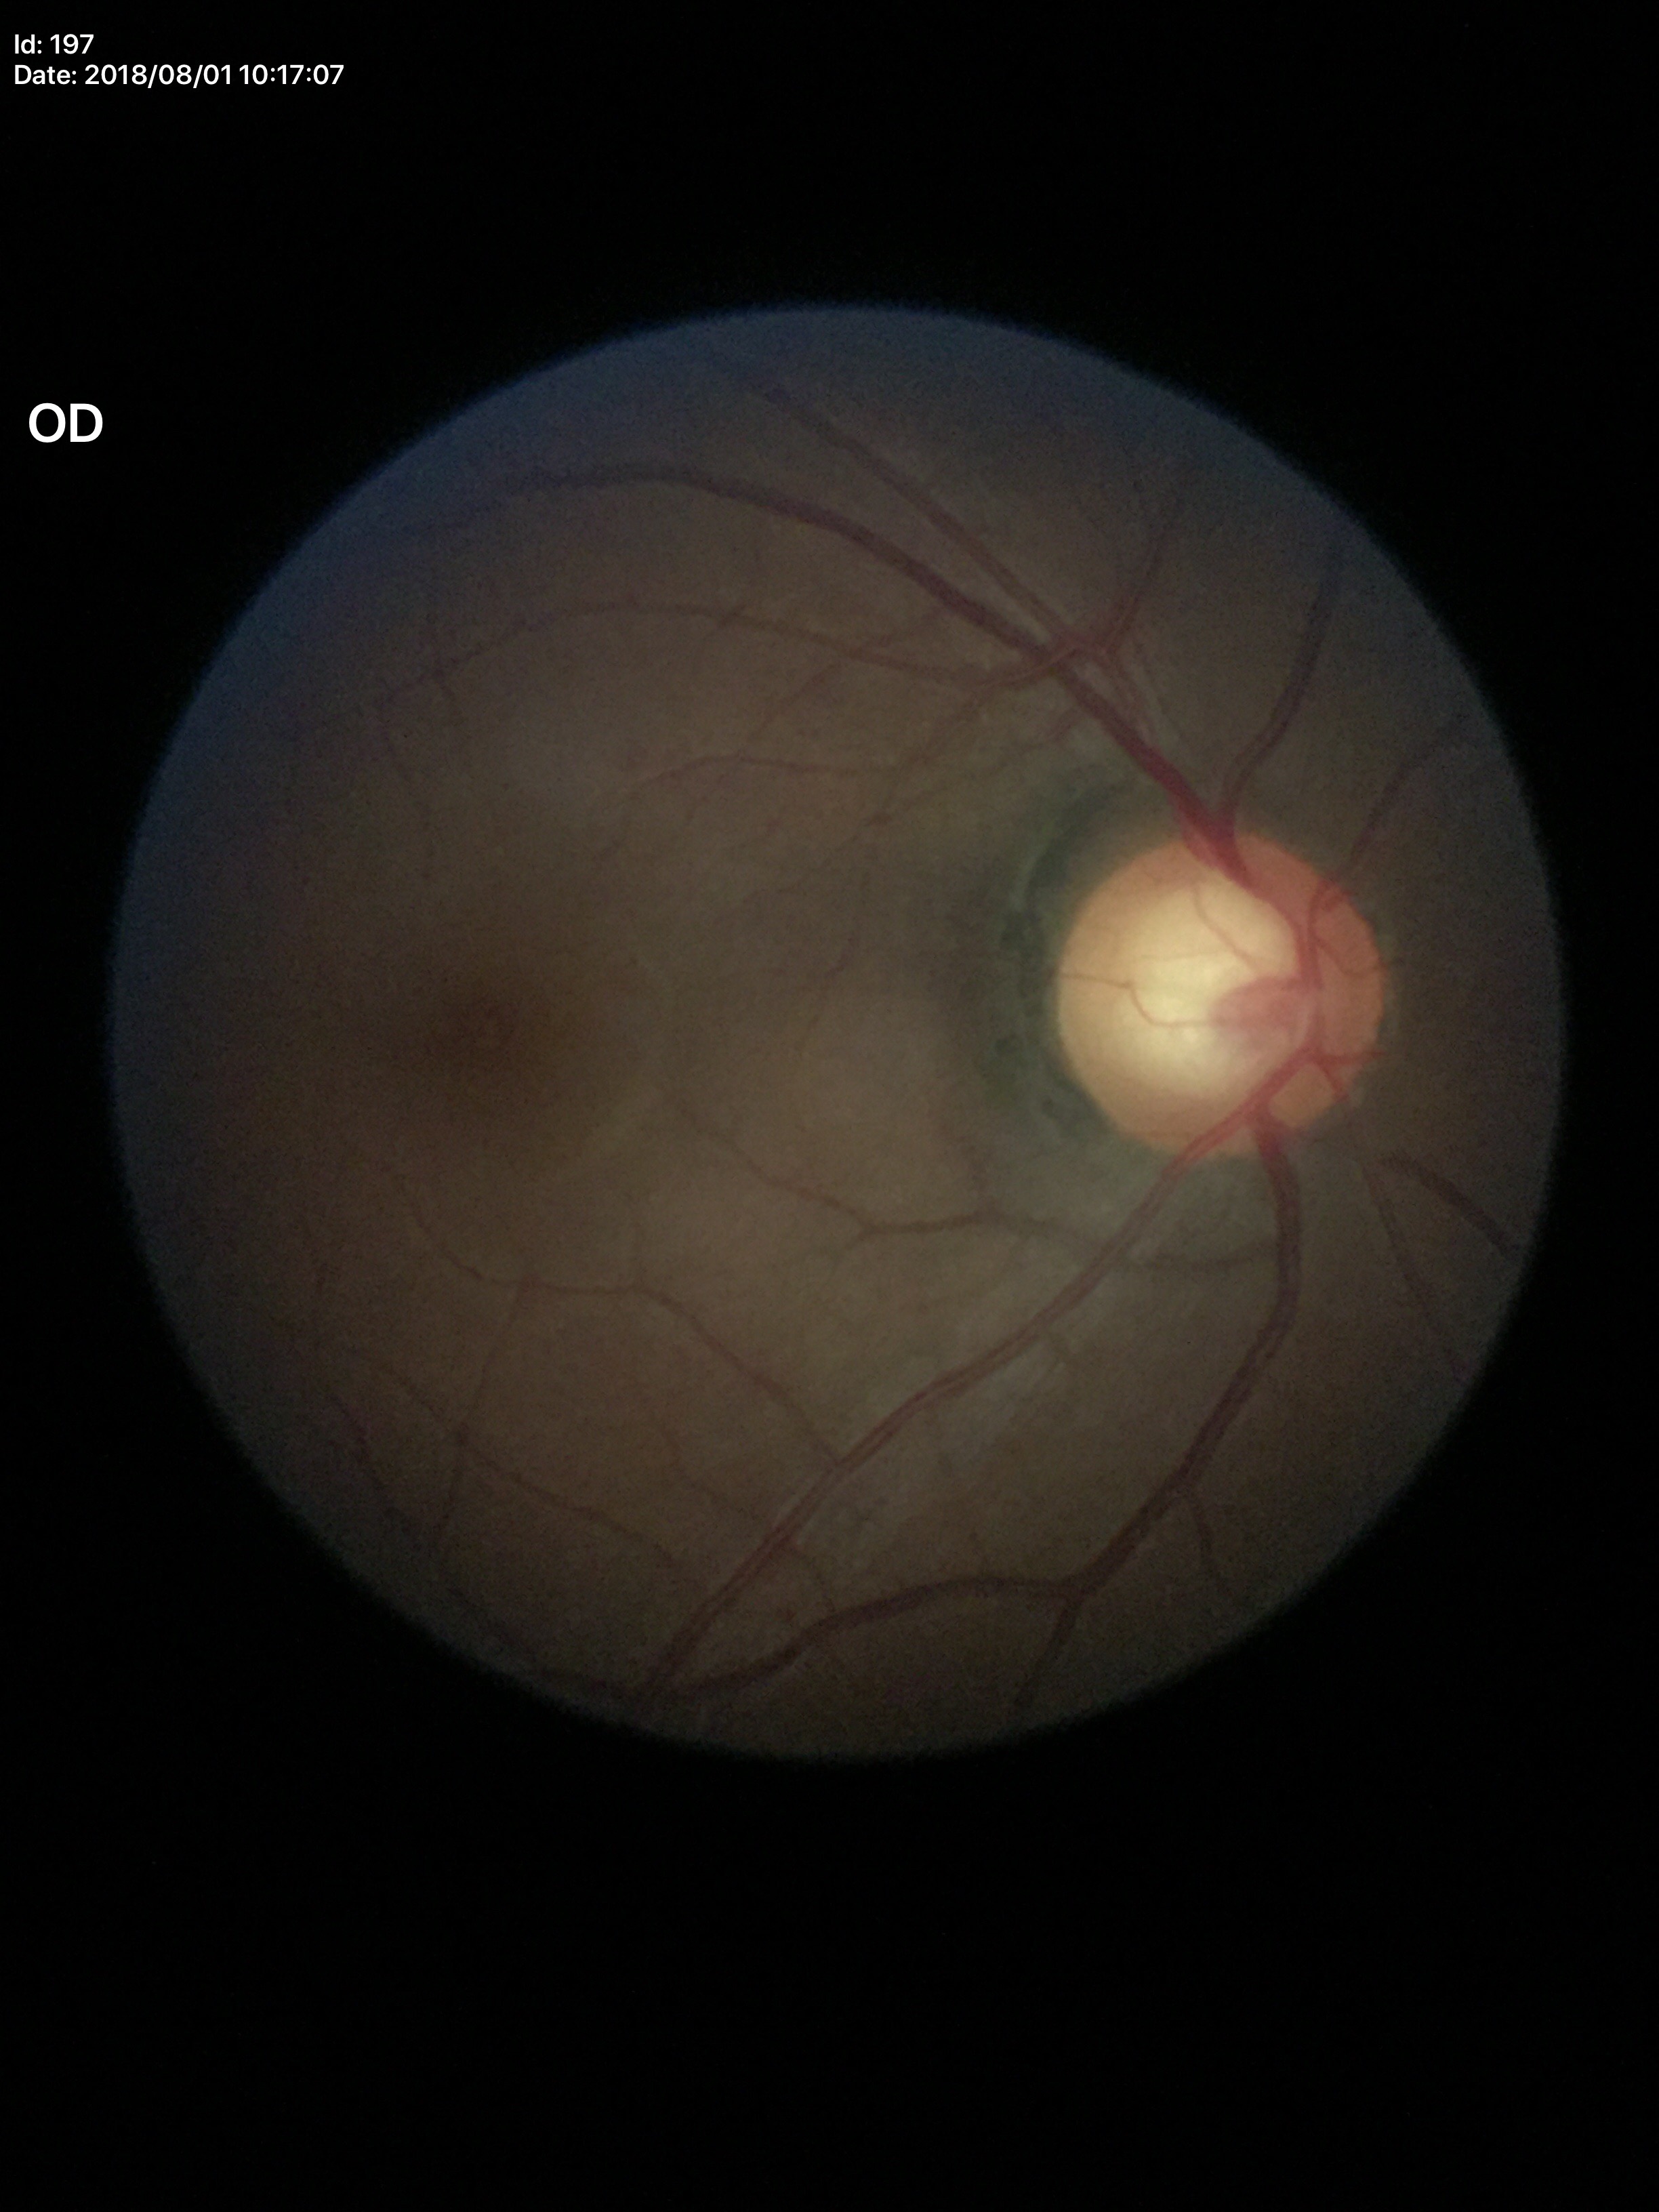
Optic disc analysis:
* Glaucoma evaluation — suspicious findings
* vertical cup-disc ratio — 0.67
* area CDR — 0.45
* horizontal C/D ratio — 0.66